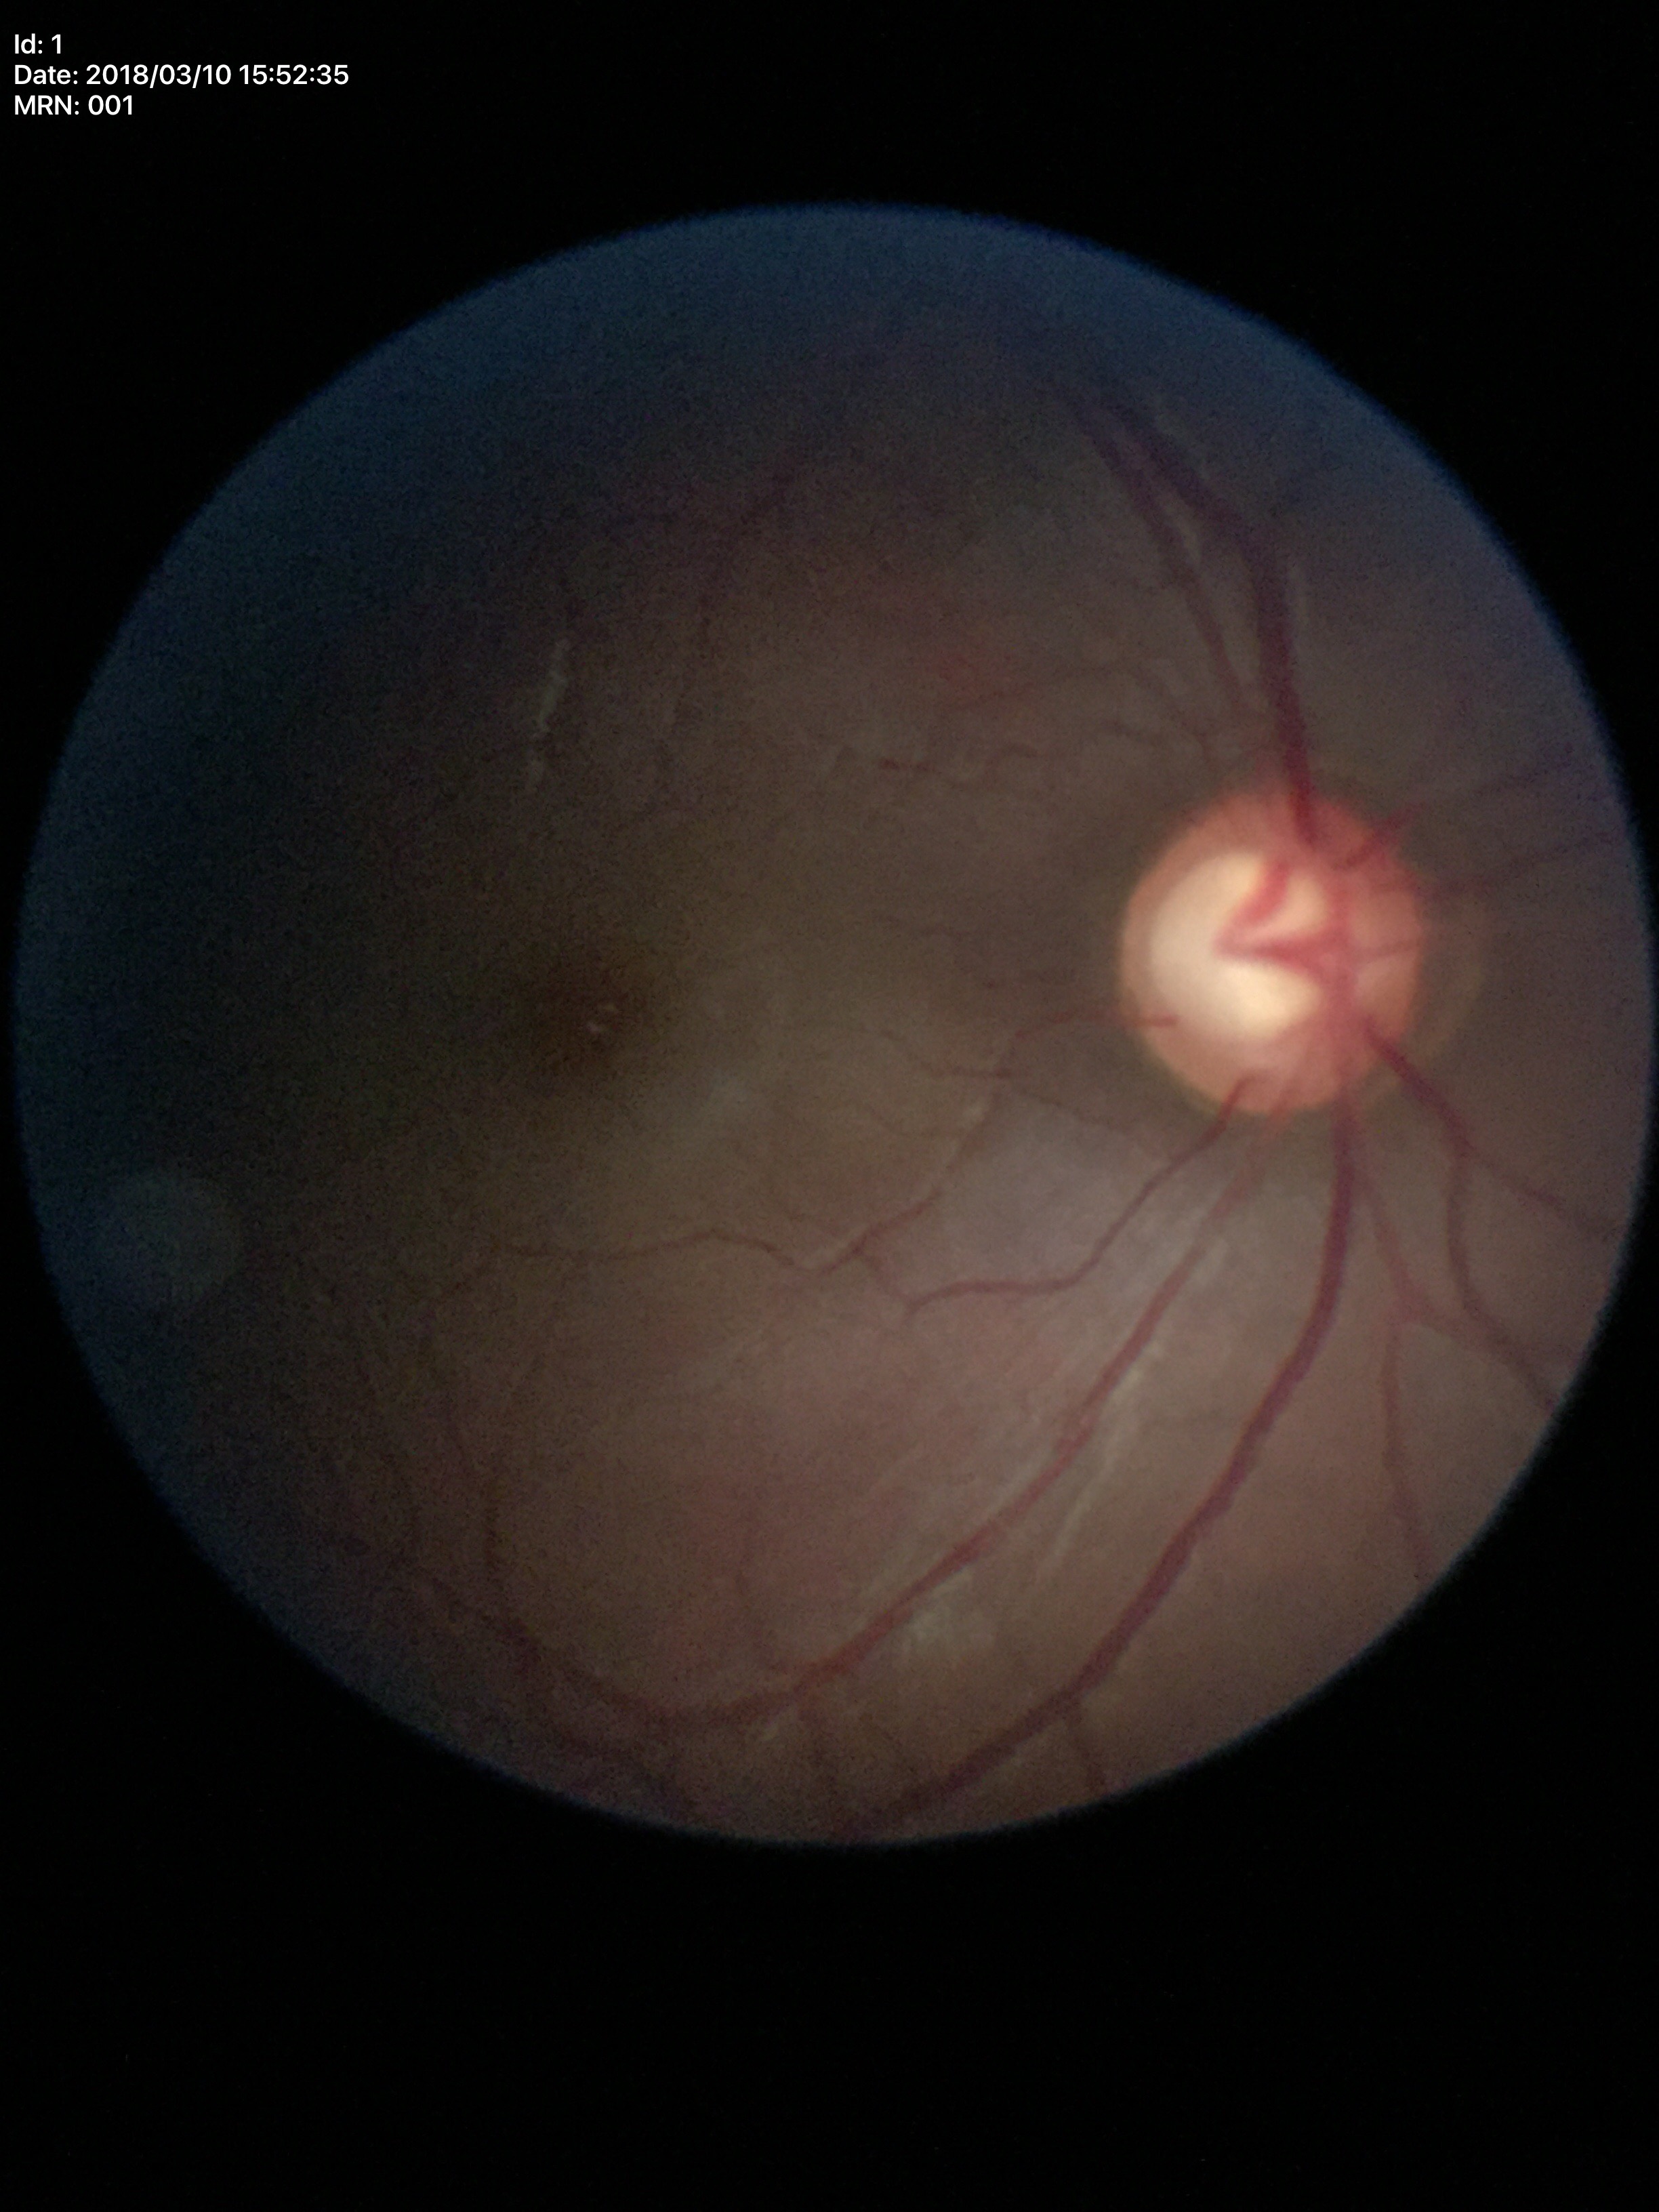

Vertical cup-to-disc ratio: 0.72. Glaucoma evaluation: suspicious (all 5 graders flagged glaucoma suspect).